2352 x 1568 pixels
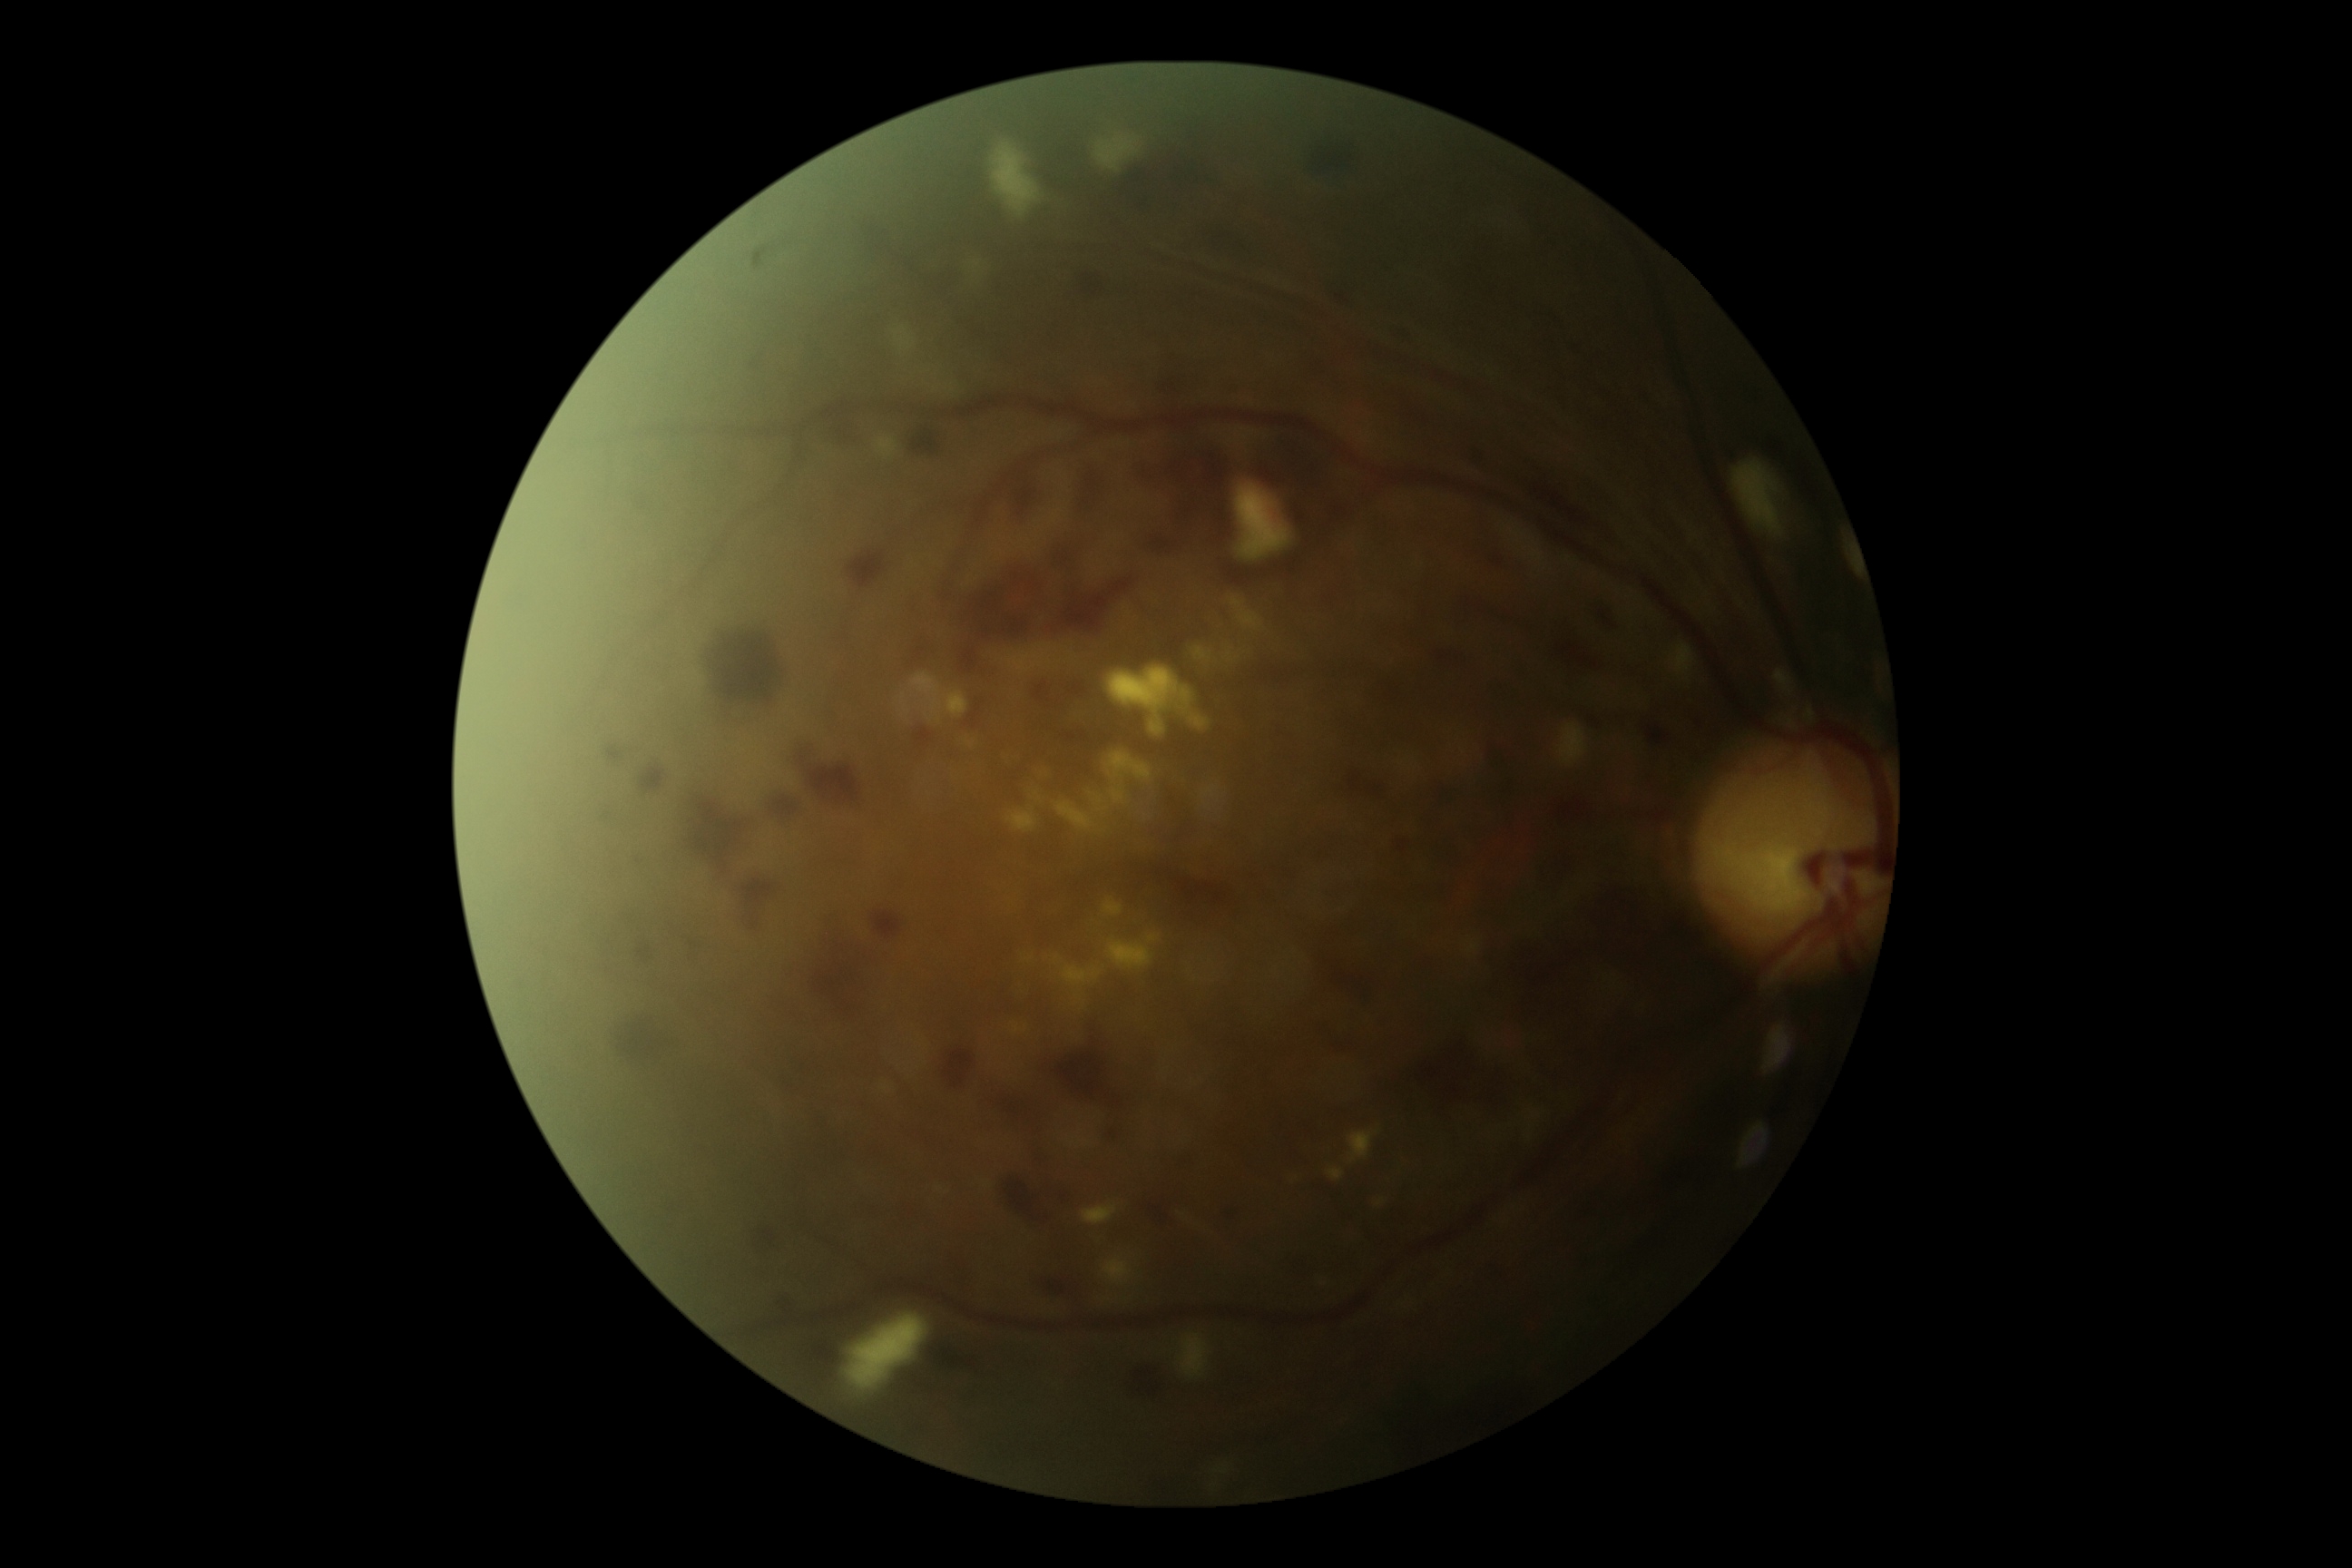

Retinopathy is severe non-proliferative diabetic retinopathy (grade 3).